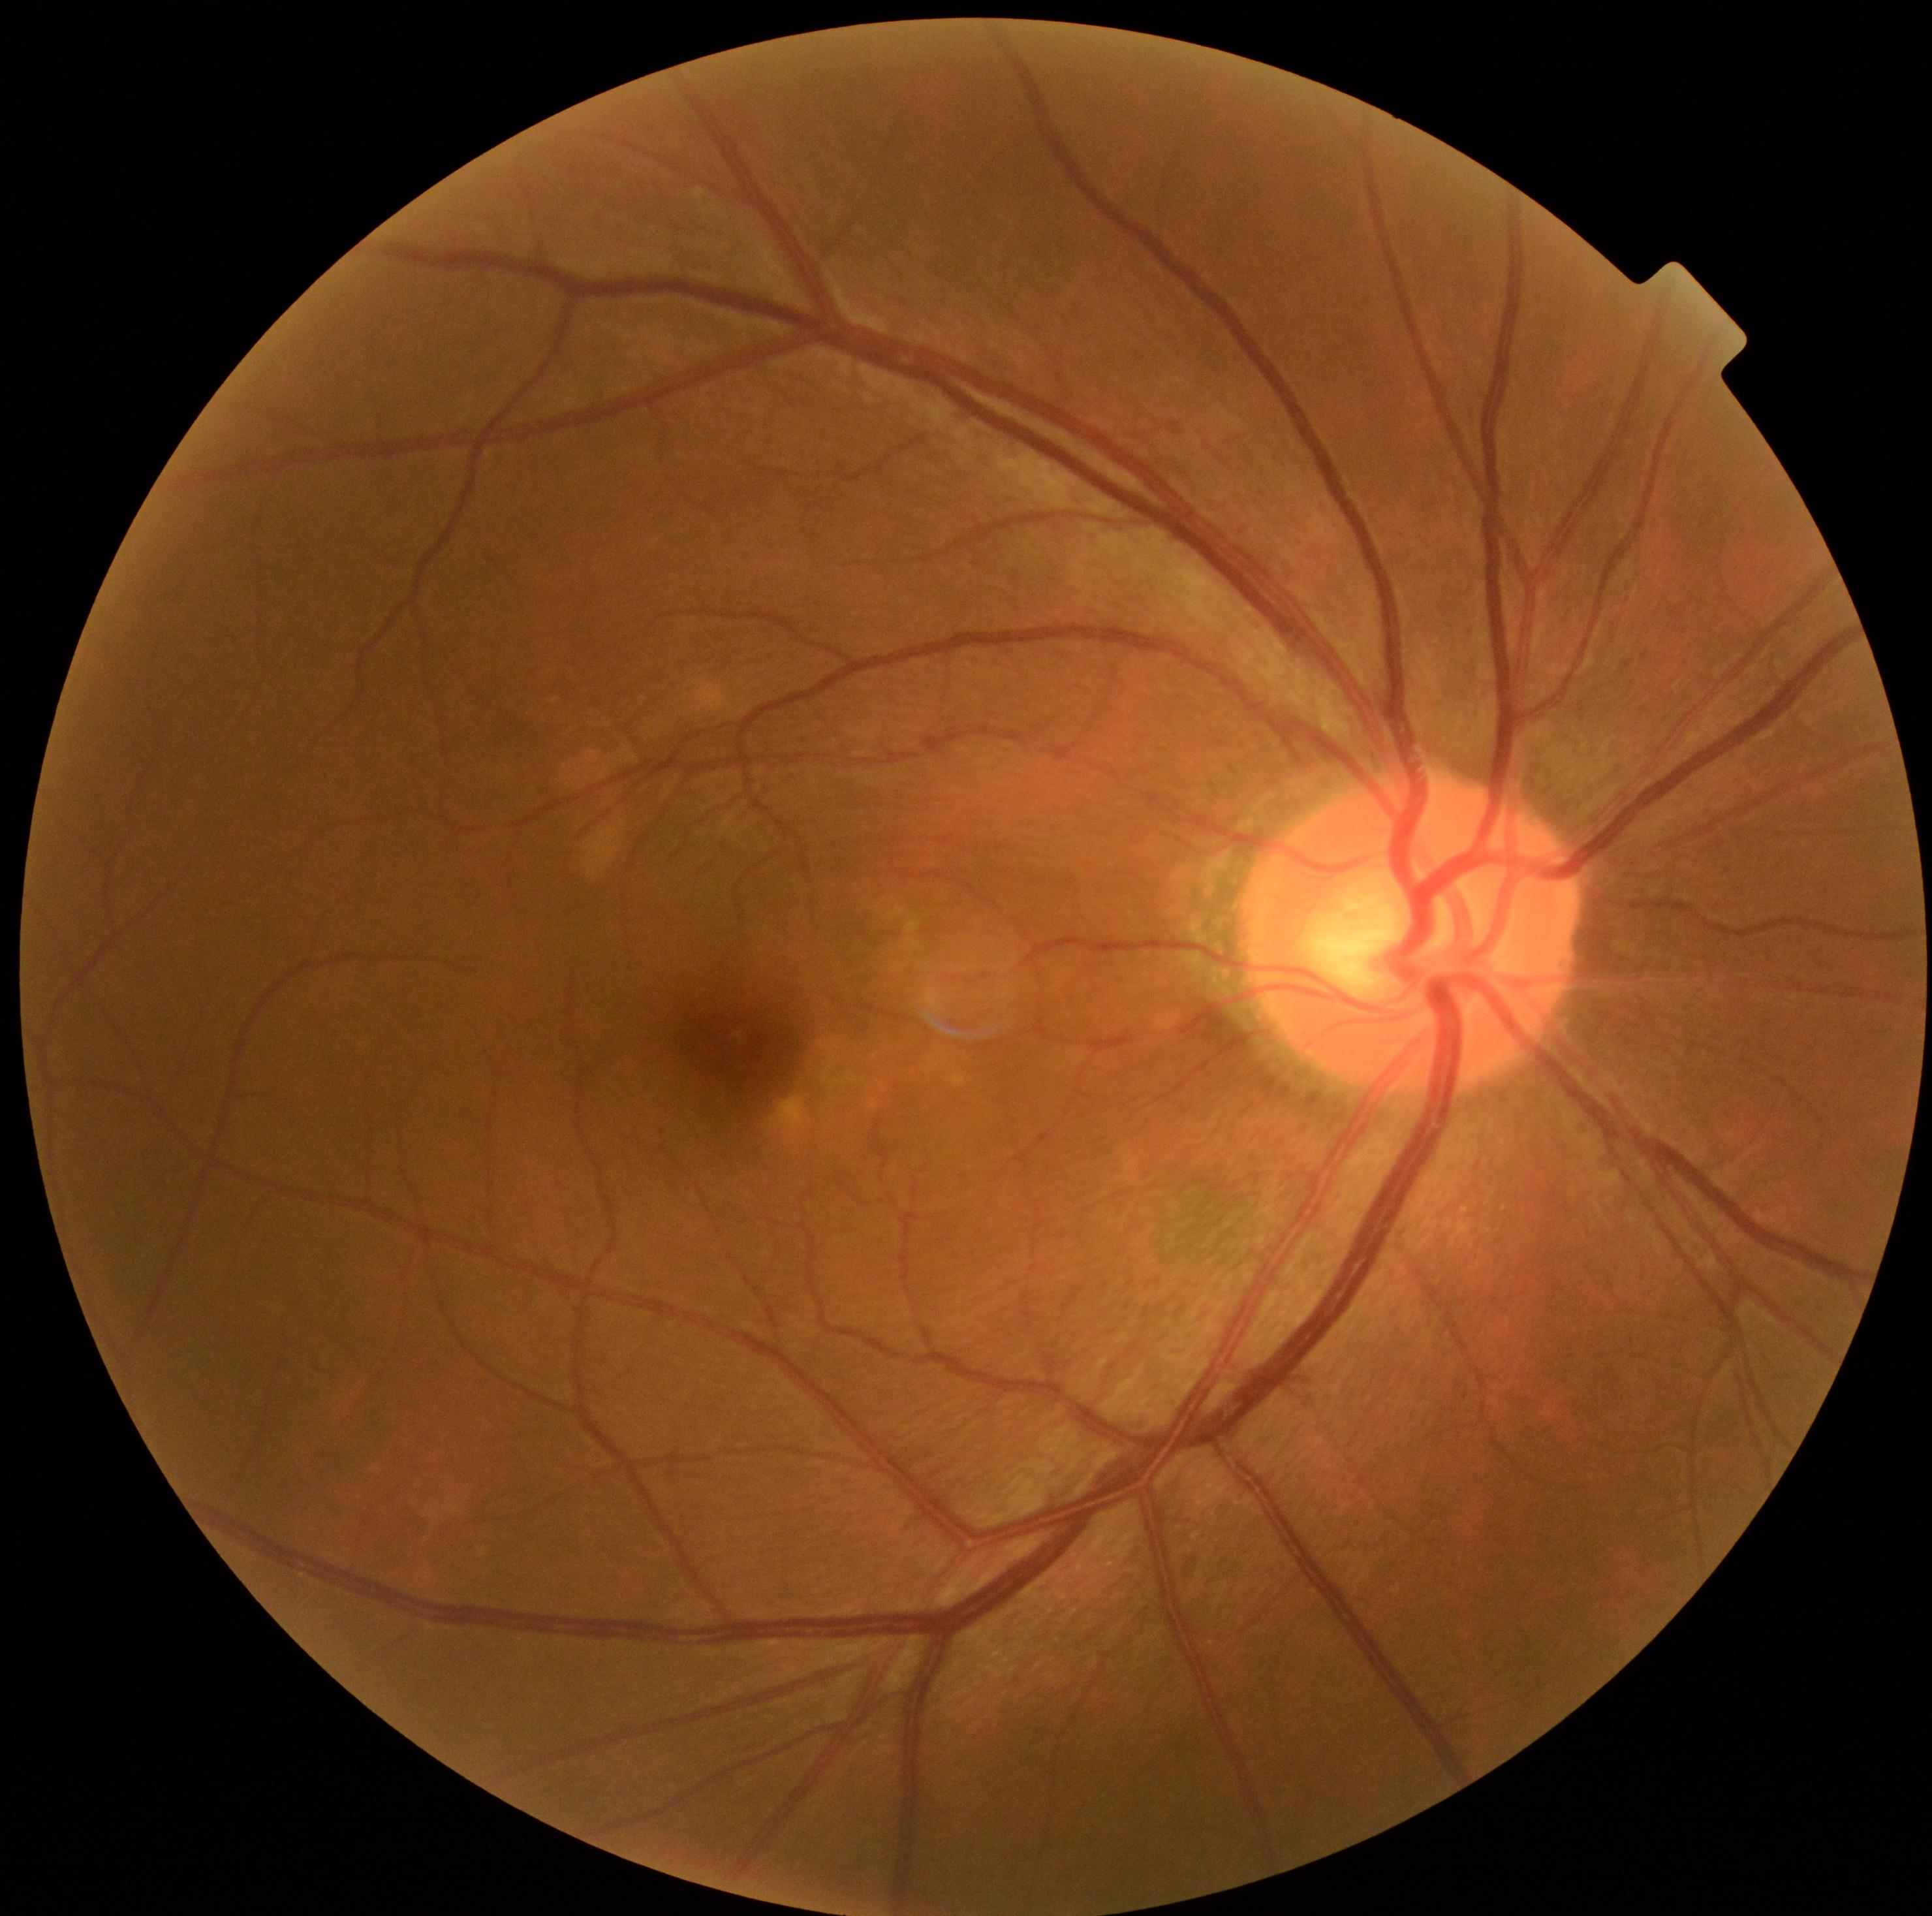

  dr_grade: no apparent retinopathy (grade 0) — no visible signs of diabetic retinopathy